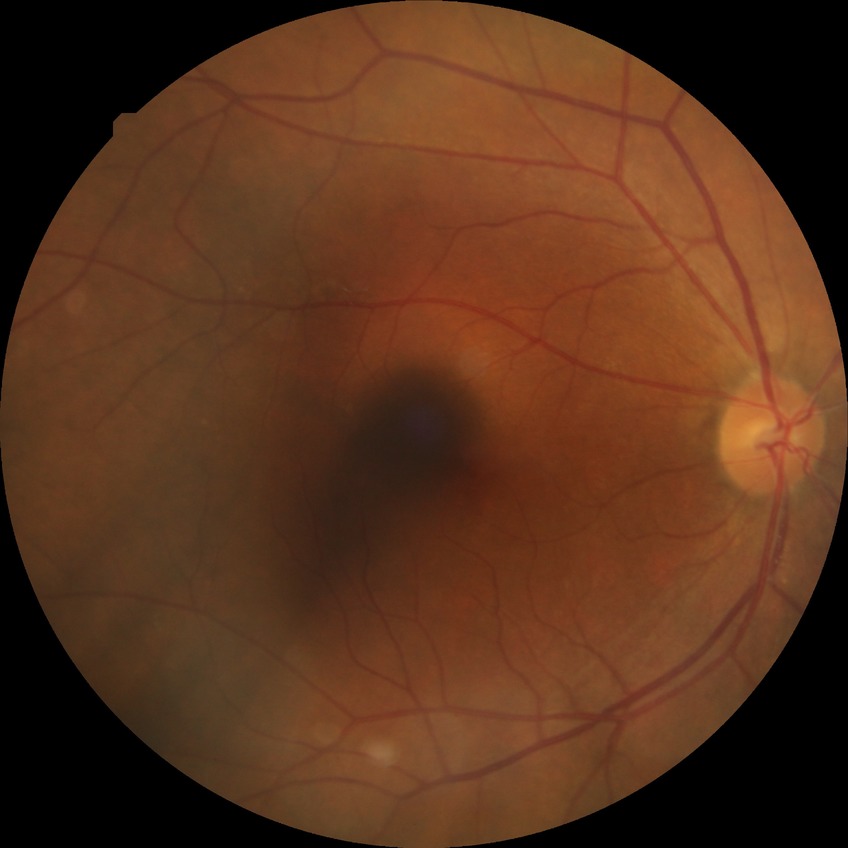 Findings:
• Davis grade — NDR